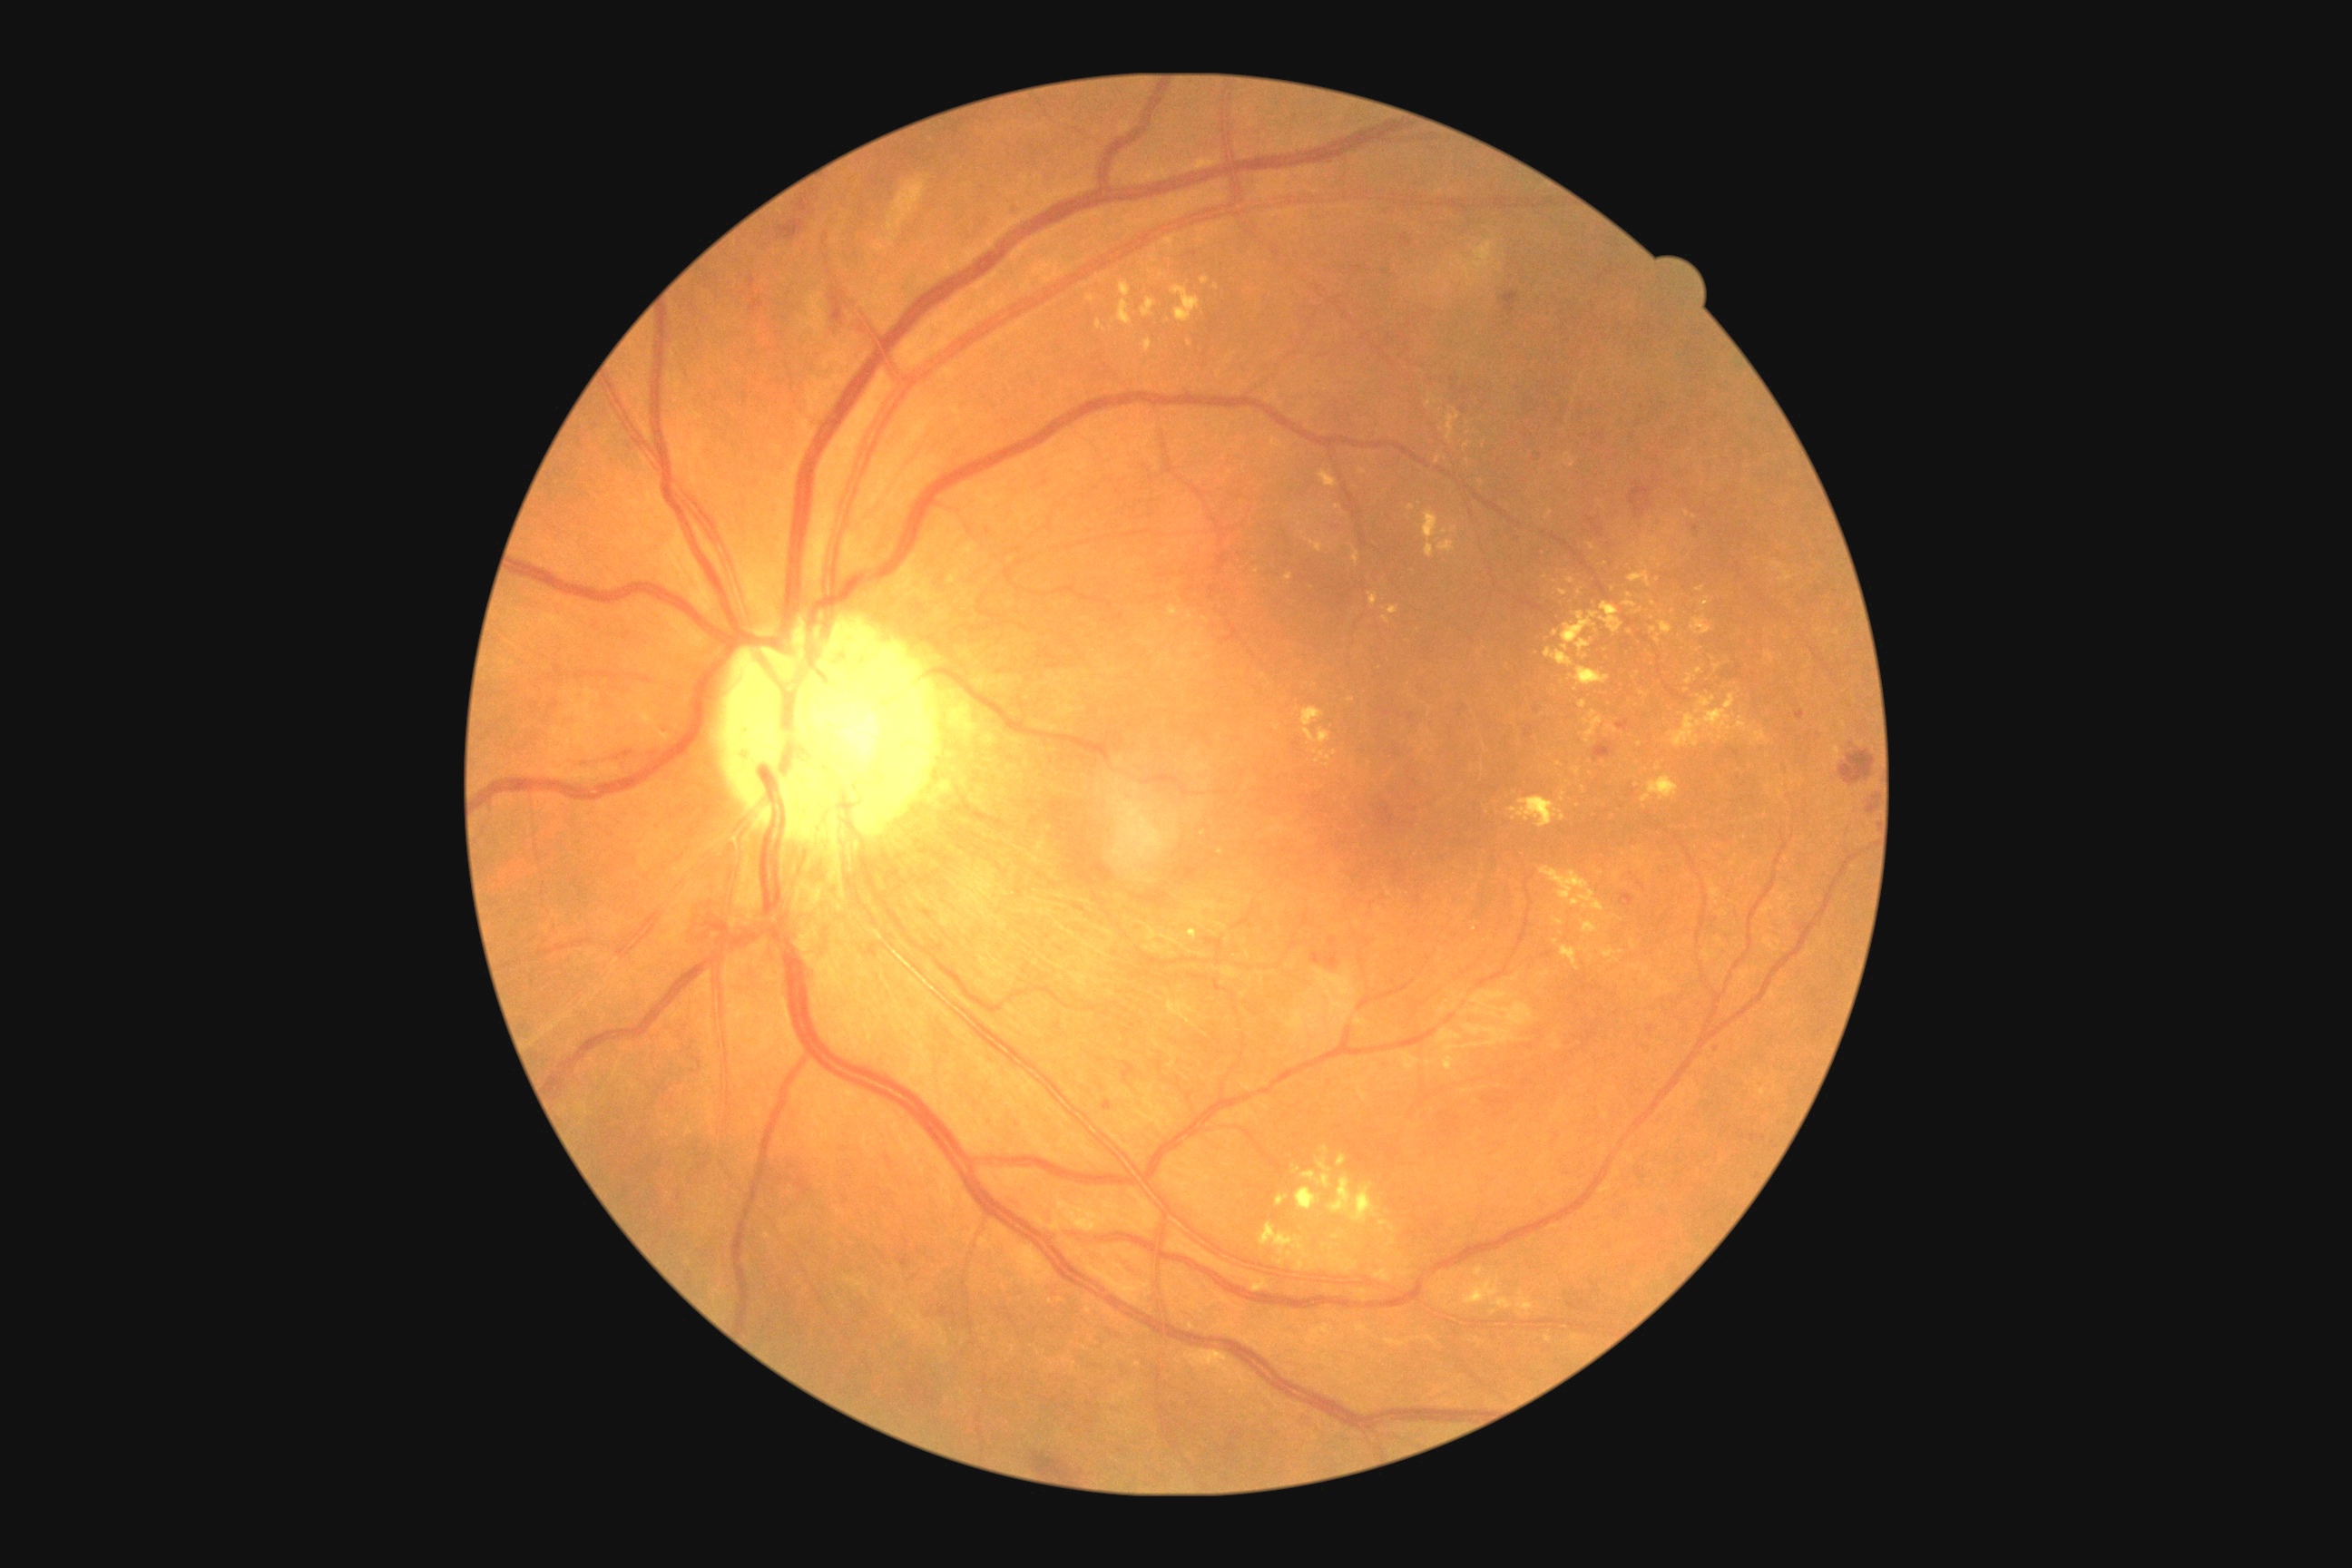 DR: grade 2. EXs are present, including at l=1540, t=867, r=1605, b=914, l=1634, t=609, r=1642, b=614, l=1560, t=792, r=1567, b=803, l=1369, t=594, r=1378, b=607, l=1696, t=696, r=1716, b=714, l=1119, t=282, r=1132, b=299, l=1447, t=407, r=1460, b=444, l=1654, t=634, r=1660, b=645, l=1640, t=691, r=1651, b=700, l=1202, t=277, r=1210, b=286, l=1302, t=709, r=1331, b=745, l=1660, t=622, r=1672, b=634. Smaller EXs around Point(1204, 834), Point(1206, 620), Point(1334, 753), Point(1580, 592), Point(1712, 736), Point(1654, 630), Point(1644, 564), Point(1325, 1150).